Pediatric wide-field fundus photograph.
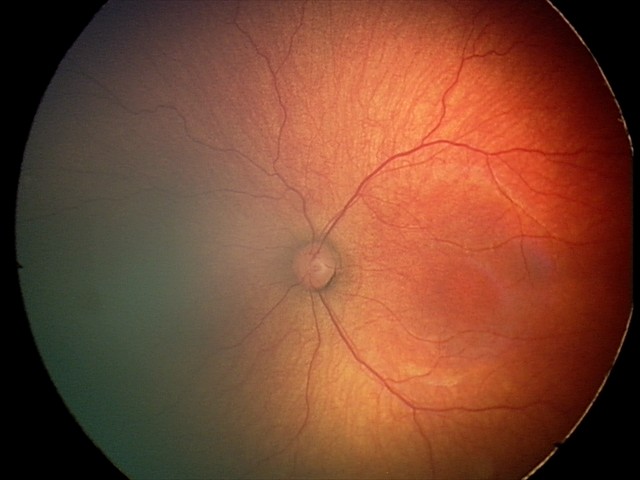 Screening examination consistent with retinopathy of prematurity stage 2. Plus disease absent.